Patient age: 55 years. IOP 14 mmHg. Central corneal thickness: 514 µm. Female patient. Autorefraction: sphere +0.25 D, cylinder -0.25 D, axis 115° — 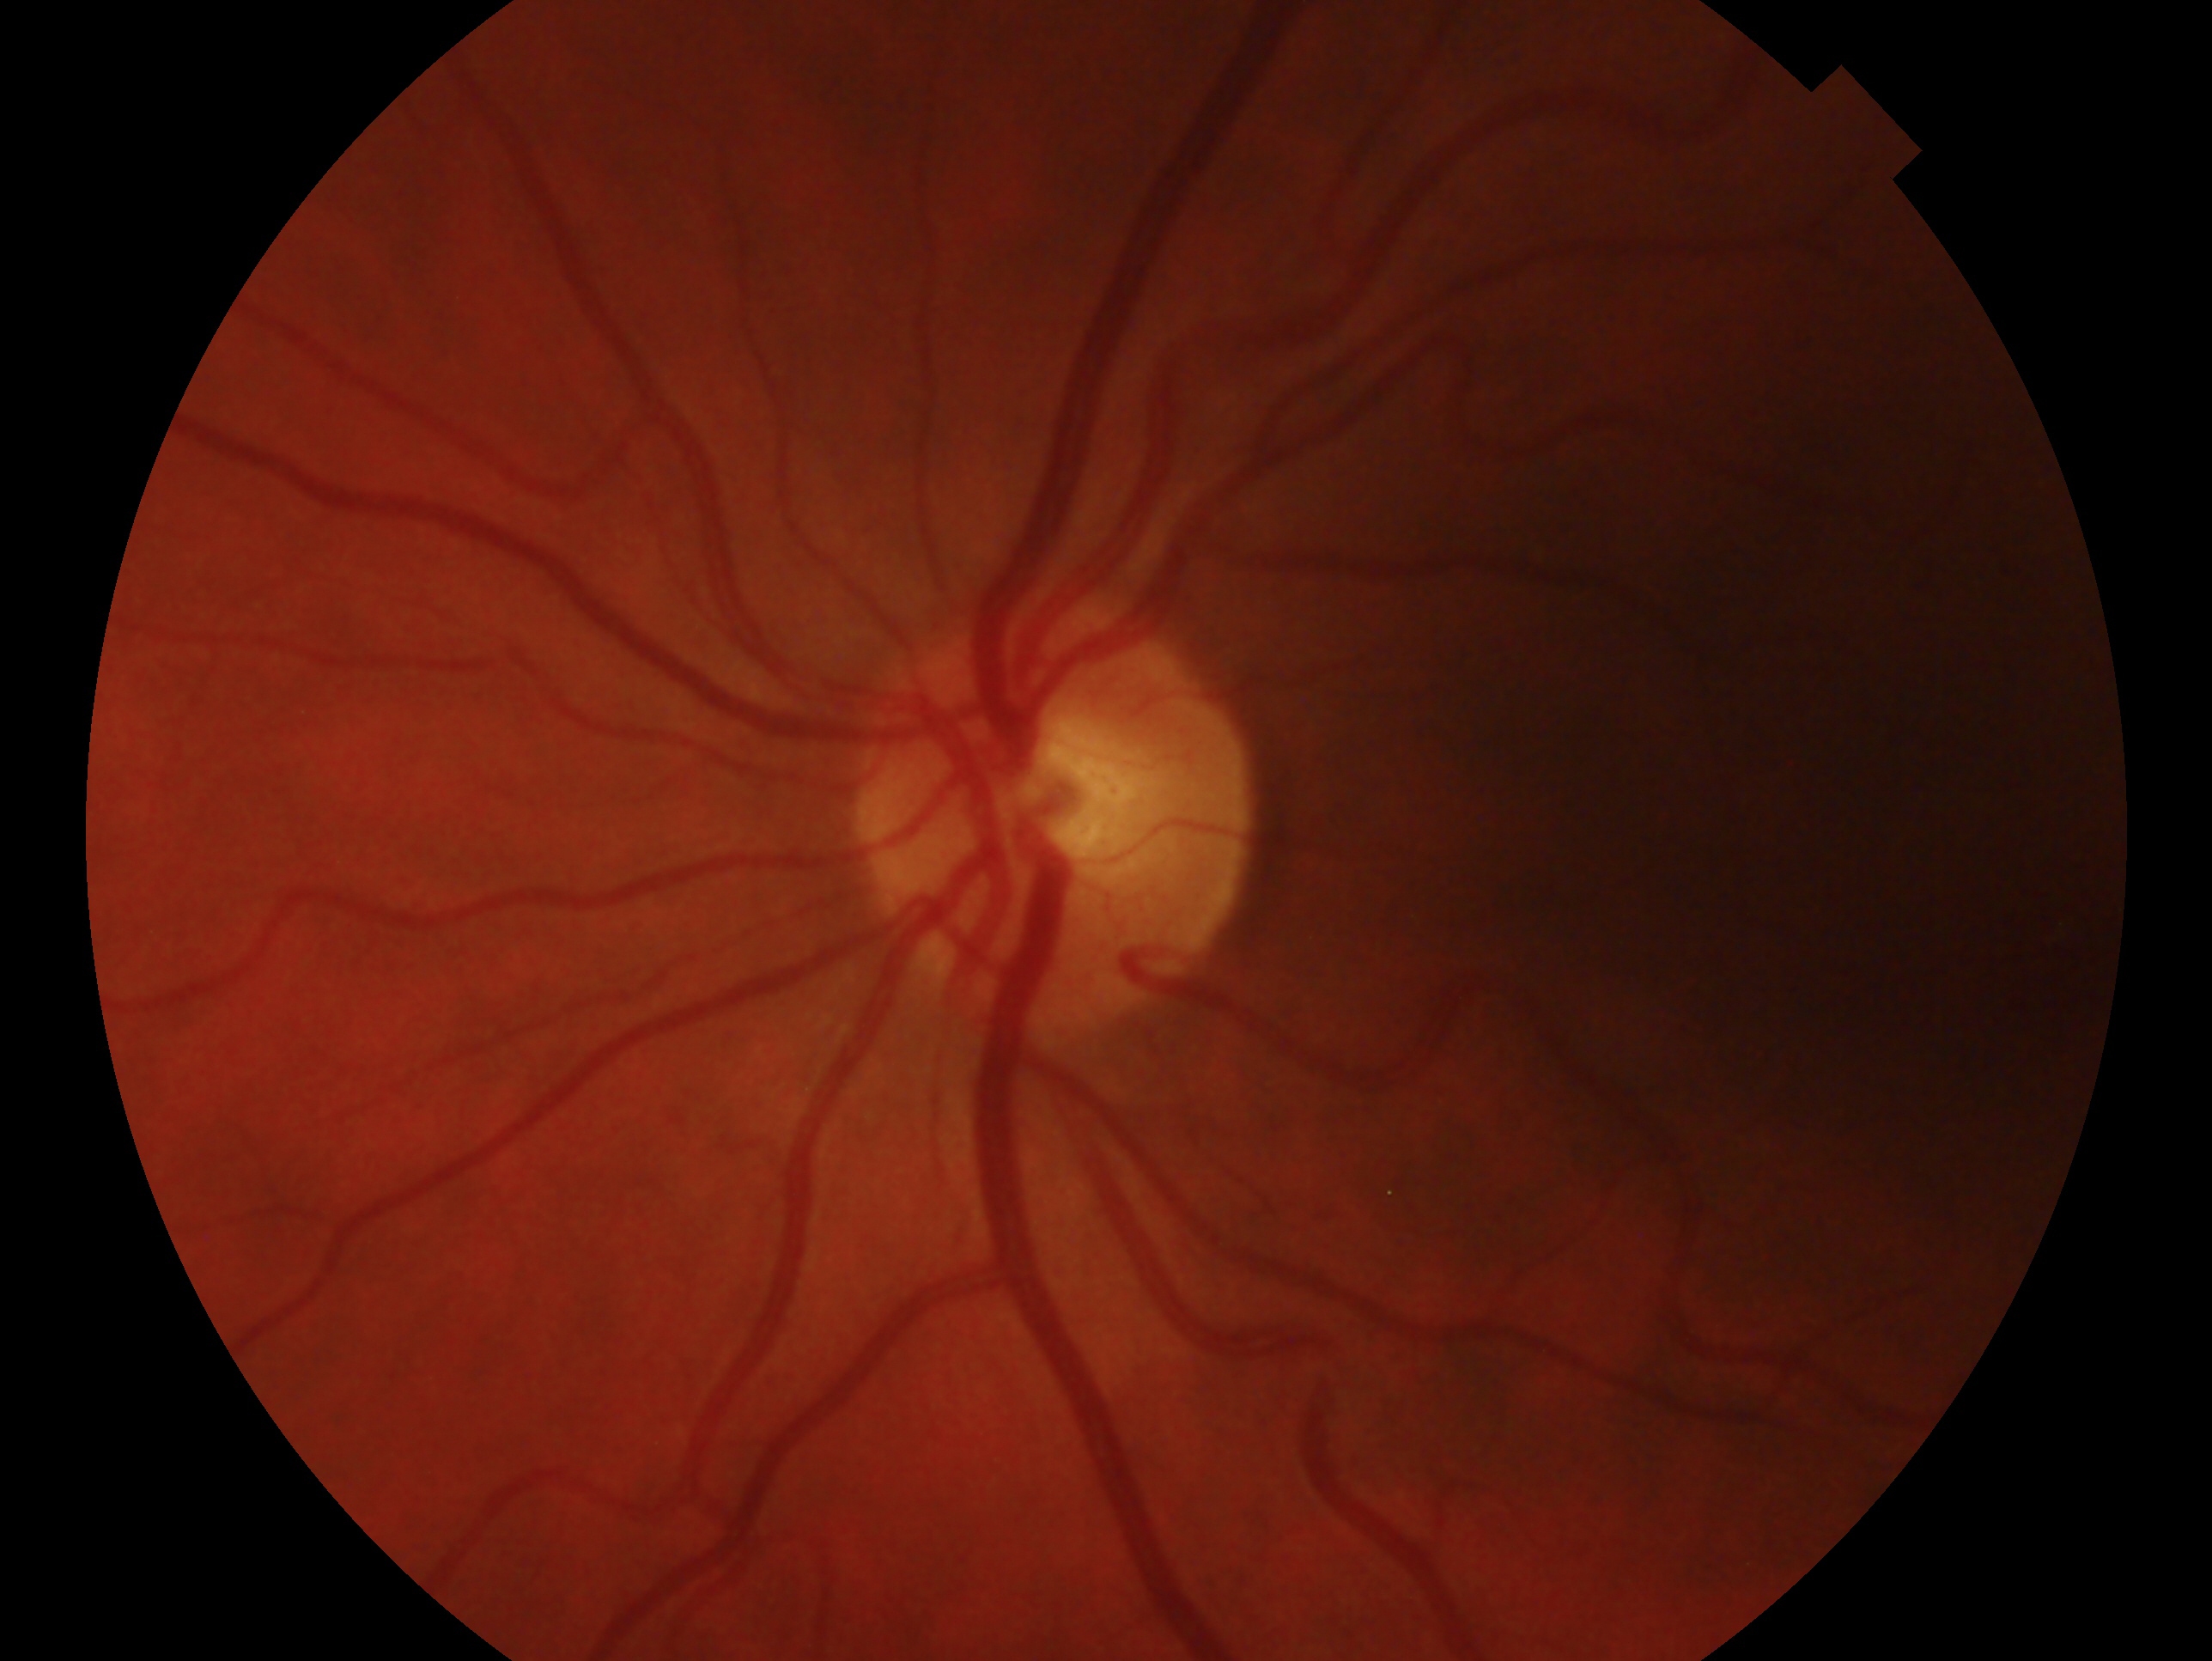
diagnosis: no glaucoma | laterality: left.